Nonmydriatic fundus photograph — 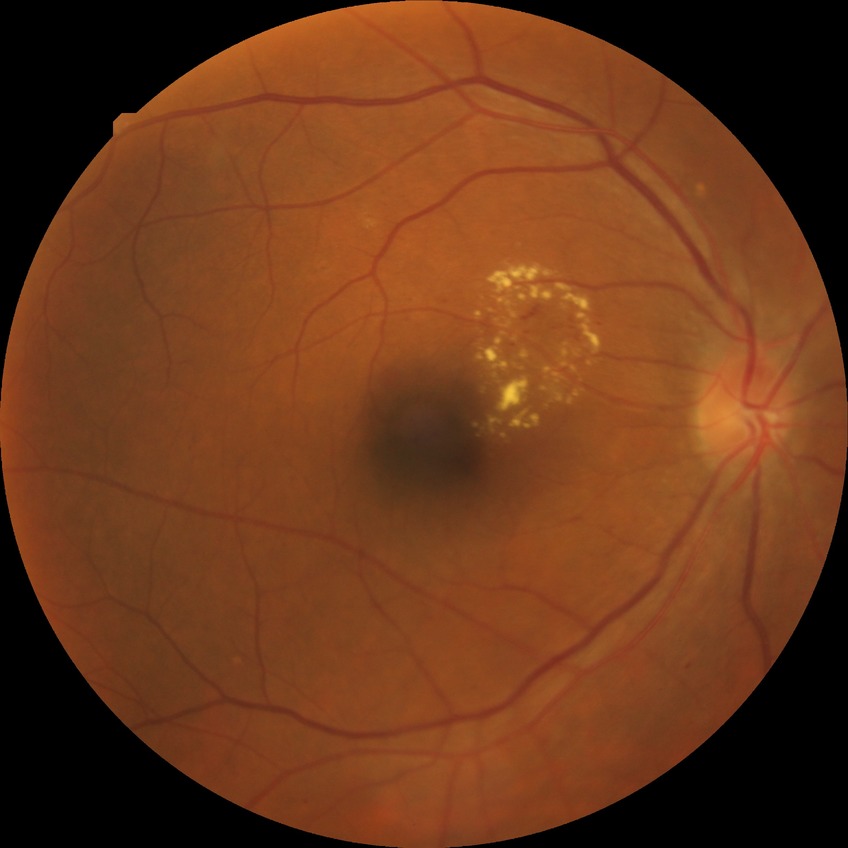 Diabetic retinopathy (DR) is simple diabetic retinopathy (SDR).